Phoenix ICON wide-field infant fundus image. 1240x1240px:
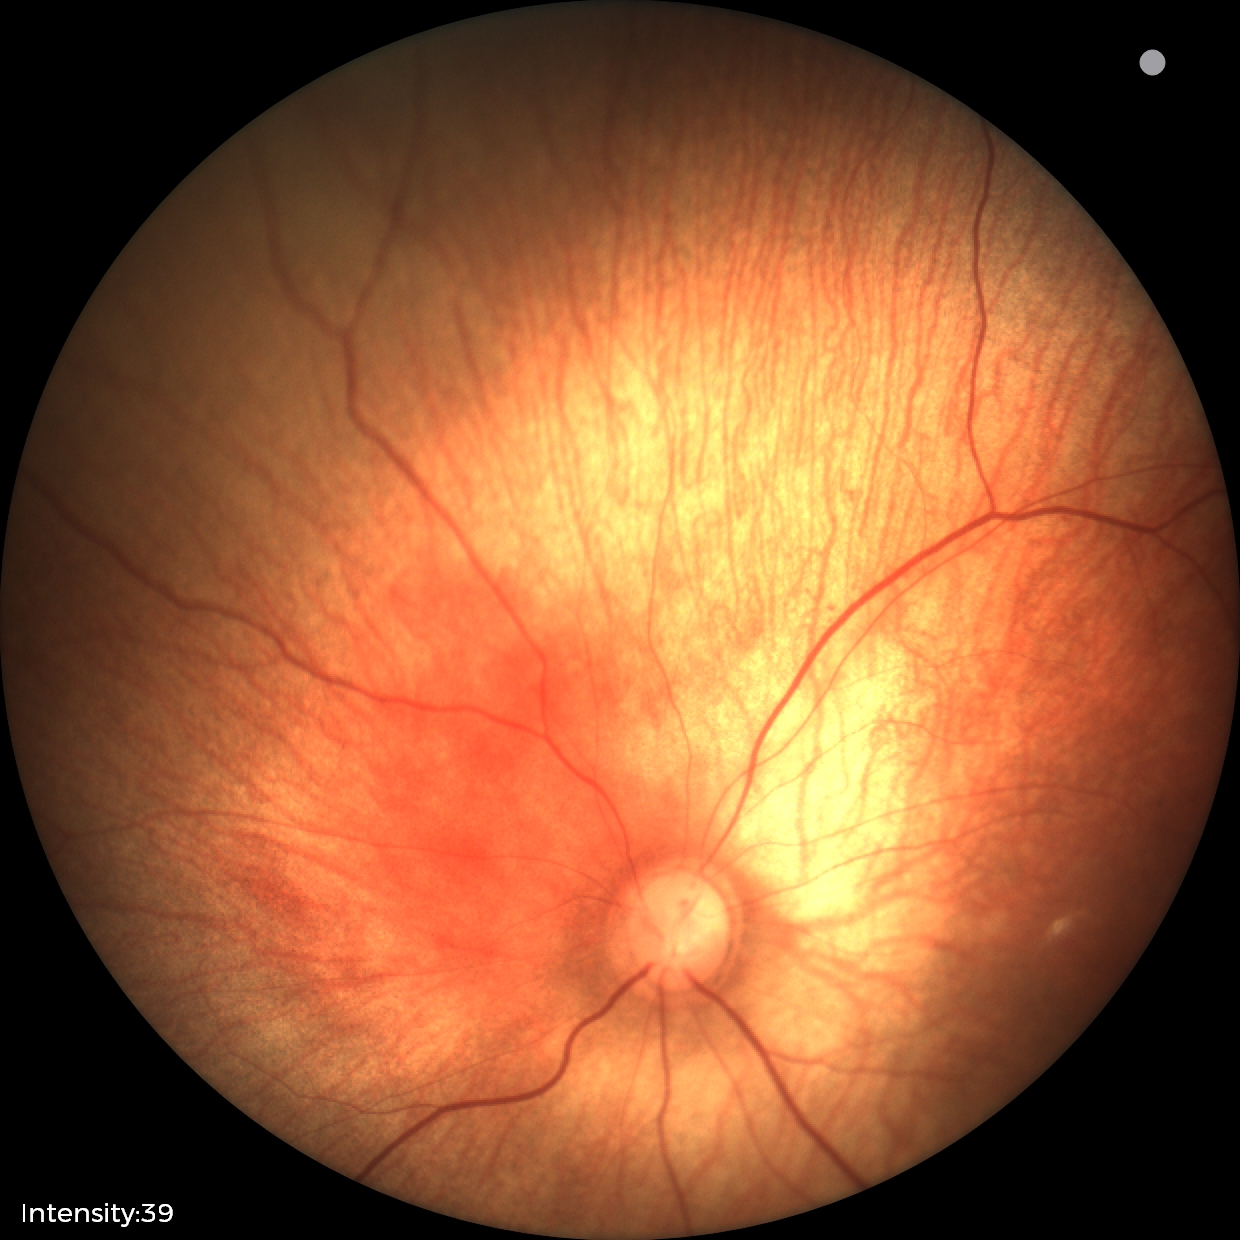 Q: What is the diagnosis from this examination?
A: physiological retinal finding